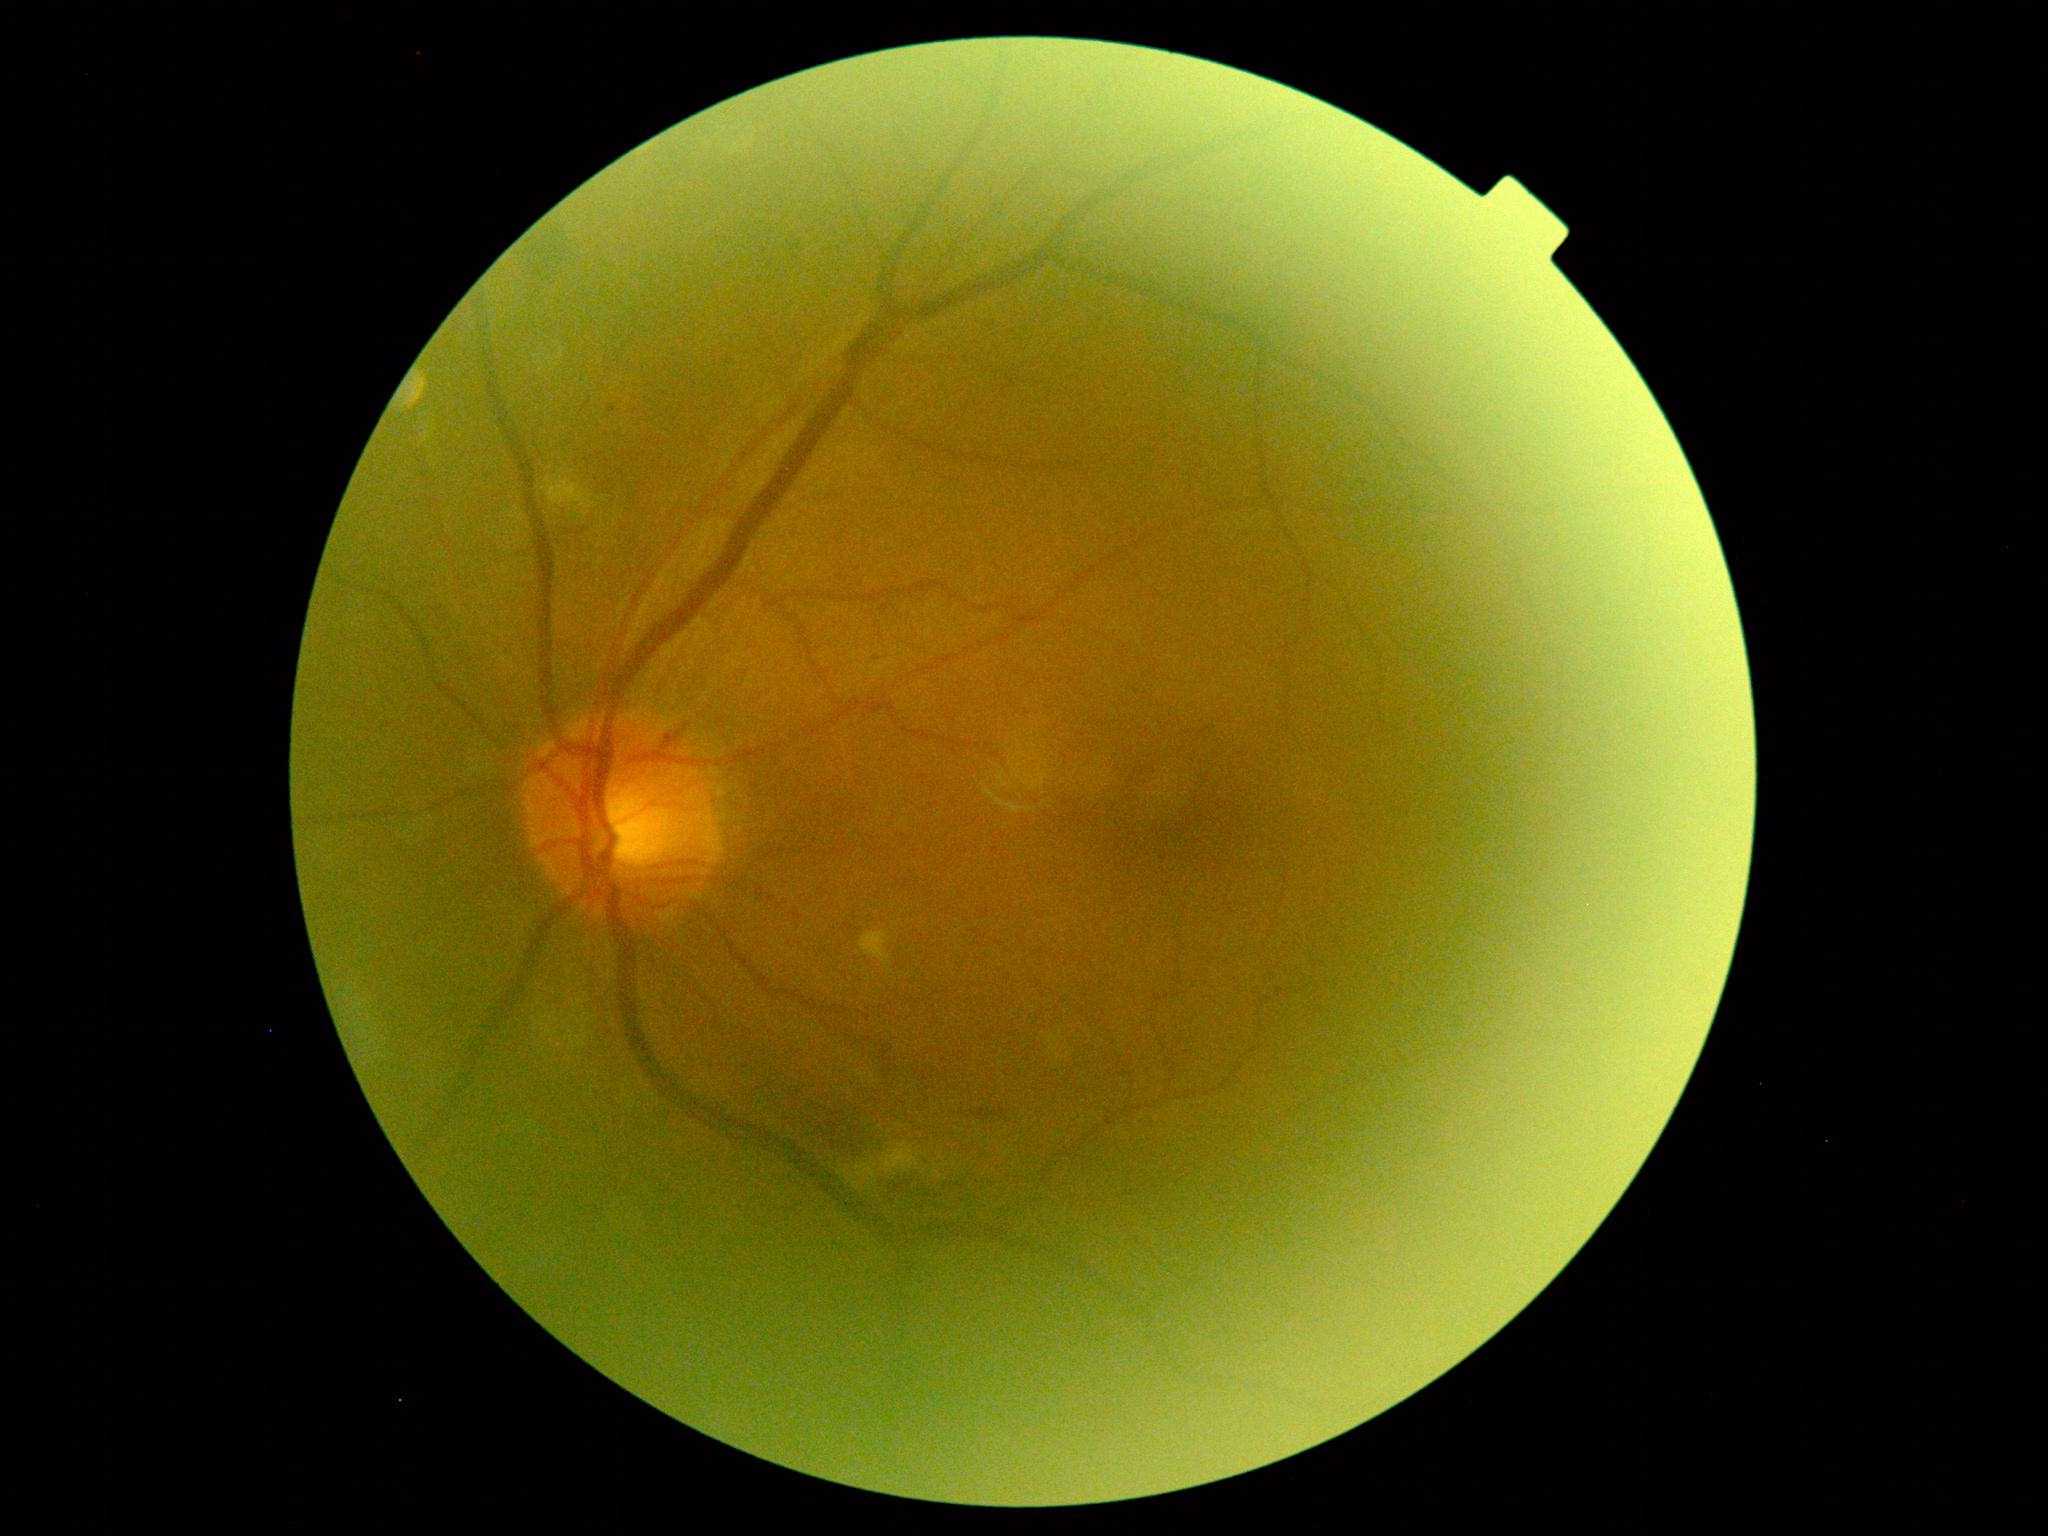 DR severity: grade 2.